Image size 2352x1568 — 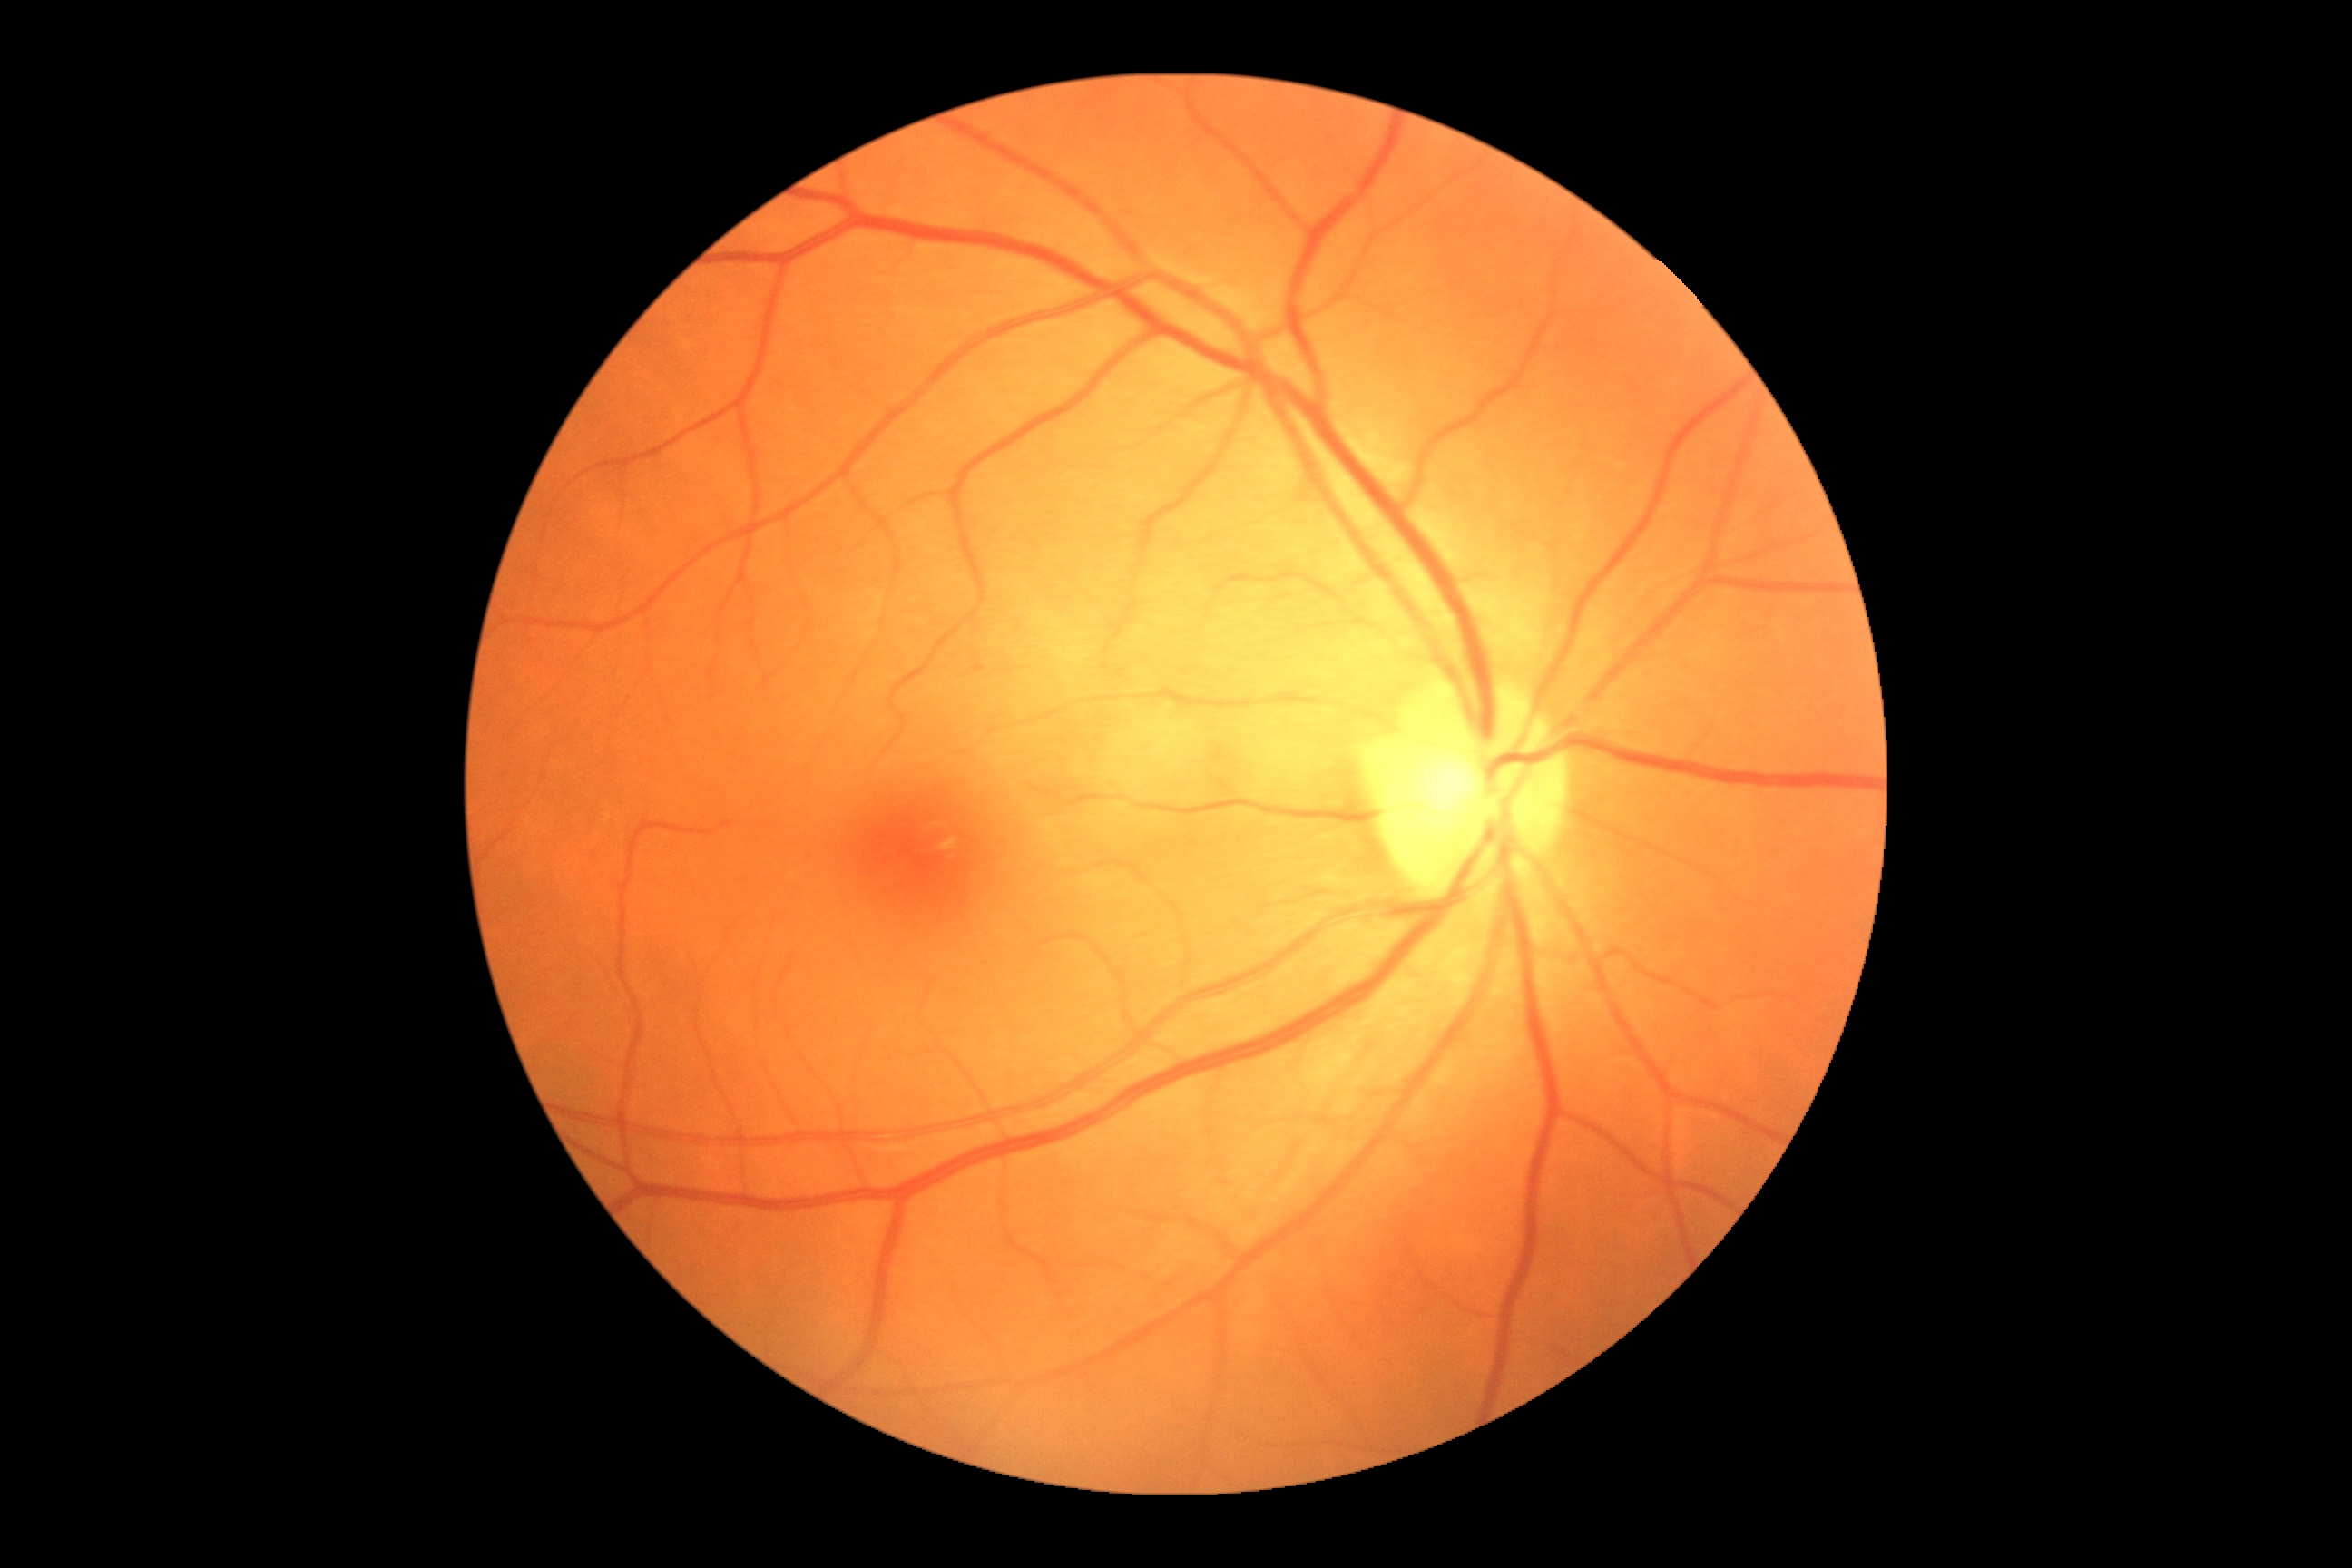 Diabetic retinopathy: grade 0 (no apparent retinopathy) — no visible signs of diabetic retinopathy.